848x848; camera: NIDEK AFC-230; nonmydriatic fundus photograph; diabetic retinopathy graded by the modified Davis classification — 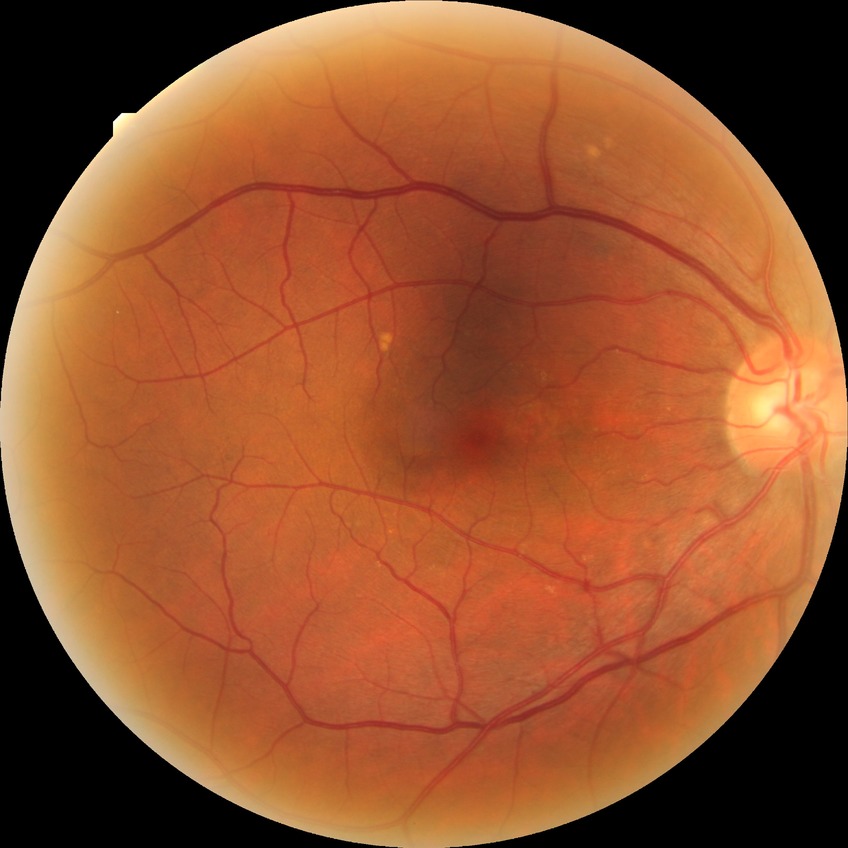 DR stage: NDR.